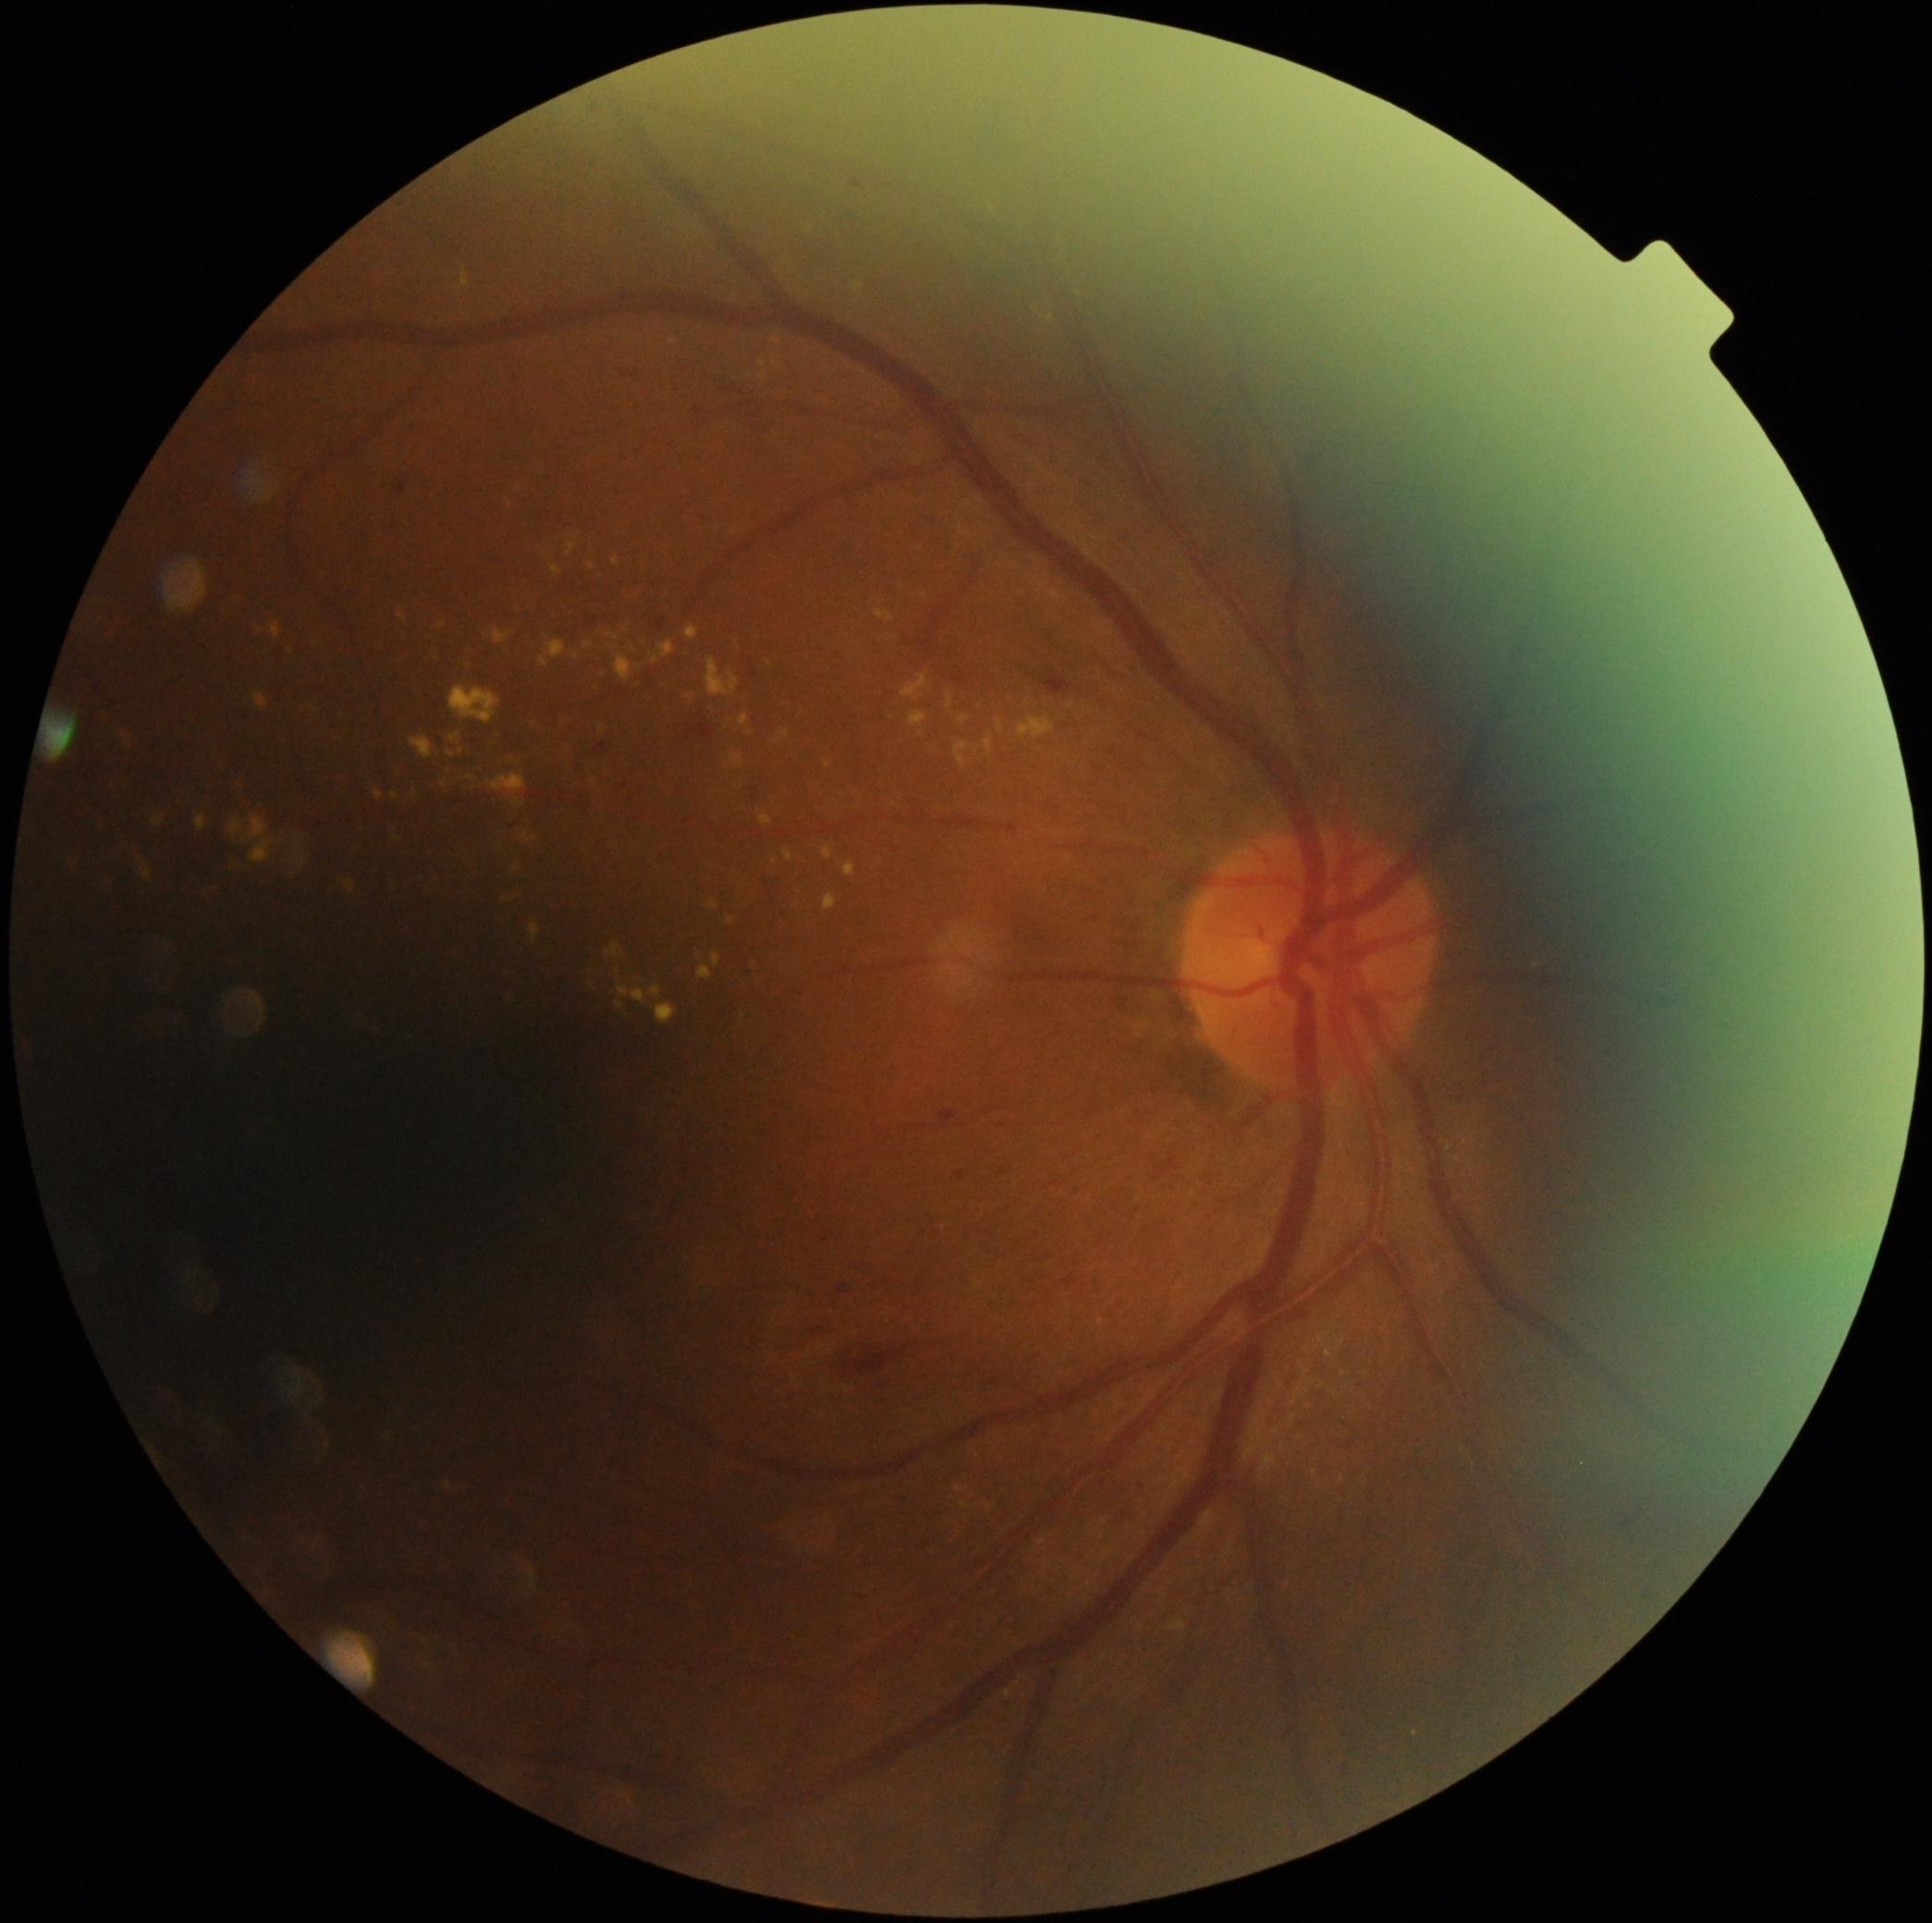

Retinopathy: grade 2 (moderate NPDR)
A subset of detected lesions:
• hard exudates (subset): 398/614/408/623; 586/642/593/651; 300/709/314/717; 760/373/767/384; 612/557/619/567; 610/645/634/680; 567/543/578/556; 616/970/621/978; 654/1004/678/1024; 462/270/470/288; 687/627/700/642; 522/832/539/845; 823/892/838/913; 947/692/954/709
• Smaller hard exudates around <point>514, 1000</point>; <point>449, 1486</point>; <point>592, 567</point>; <point>924, 595</point>; <point>1072, 706</point>; <point>771, 664</point>